50° field of view. 1534 x 1534 pixels. Tabletop color fundus camera image
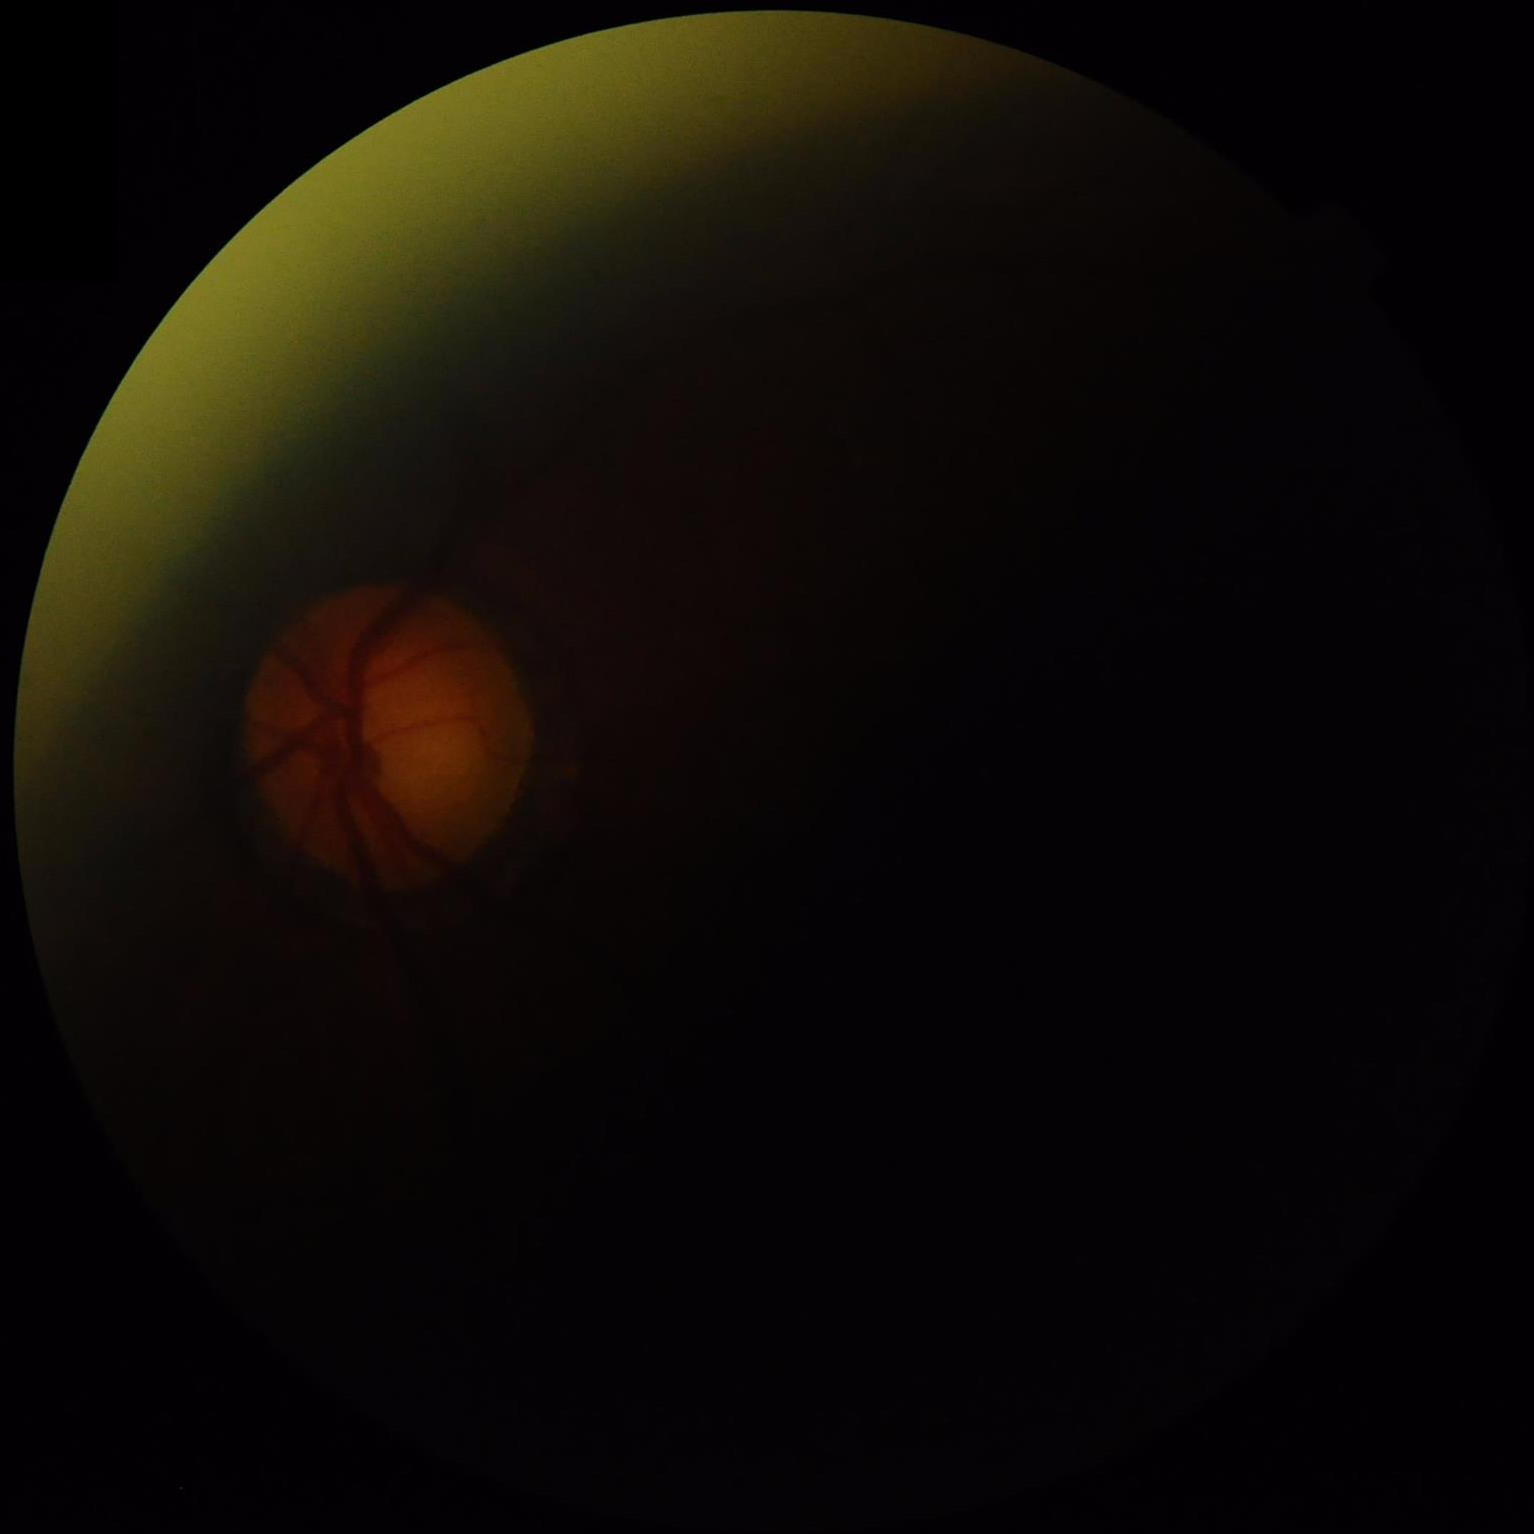
Illumination = suboptimal
Overall image quality = inadequate
Sharpness = blurry
Contrast = reduced